2352 x 1568 pixels: 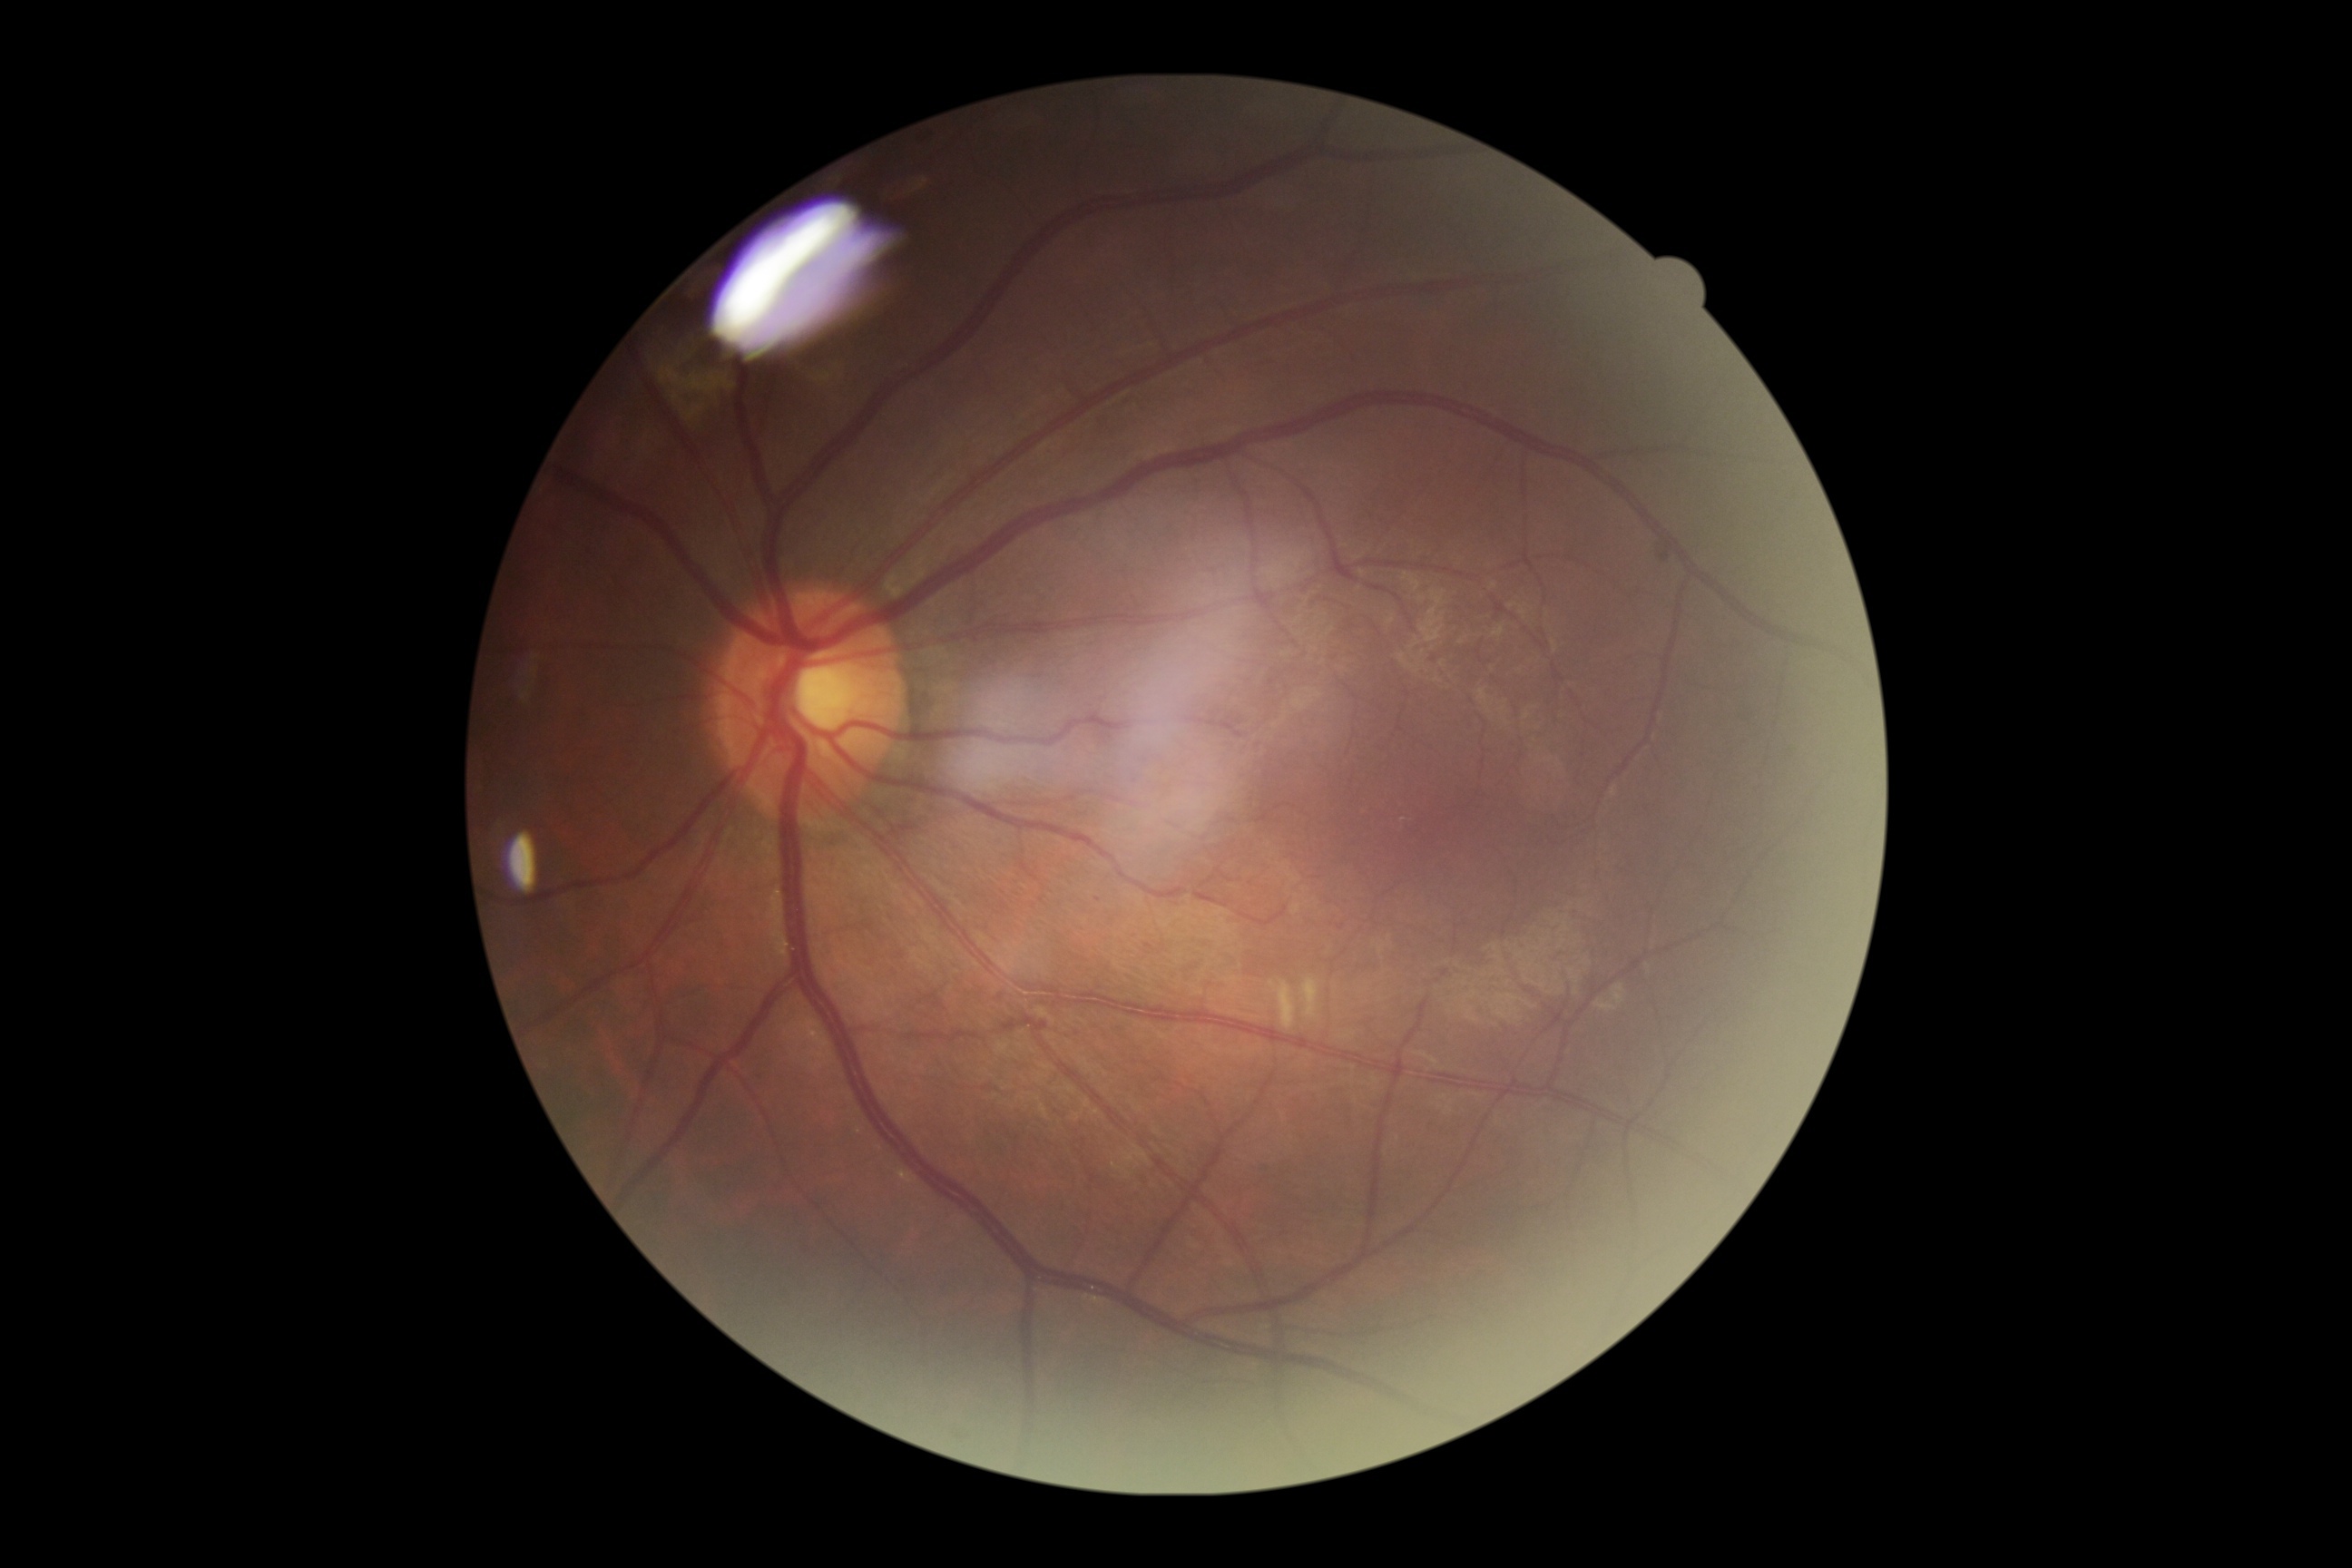
DR: grade 2 (moderate NPDR).